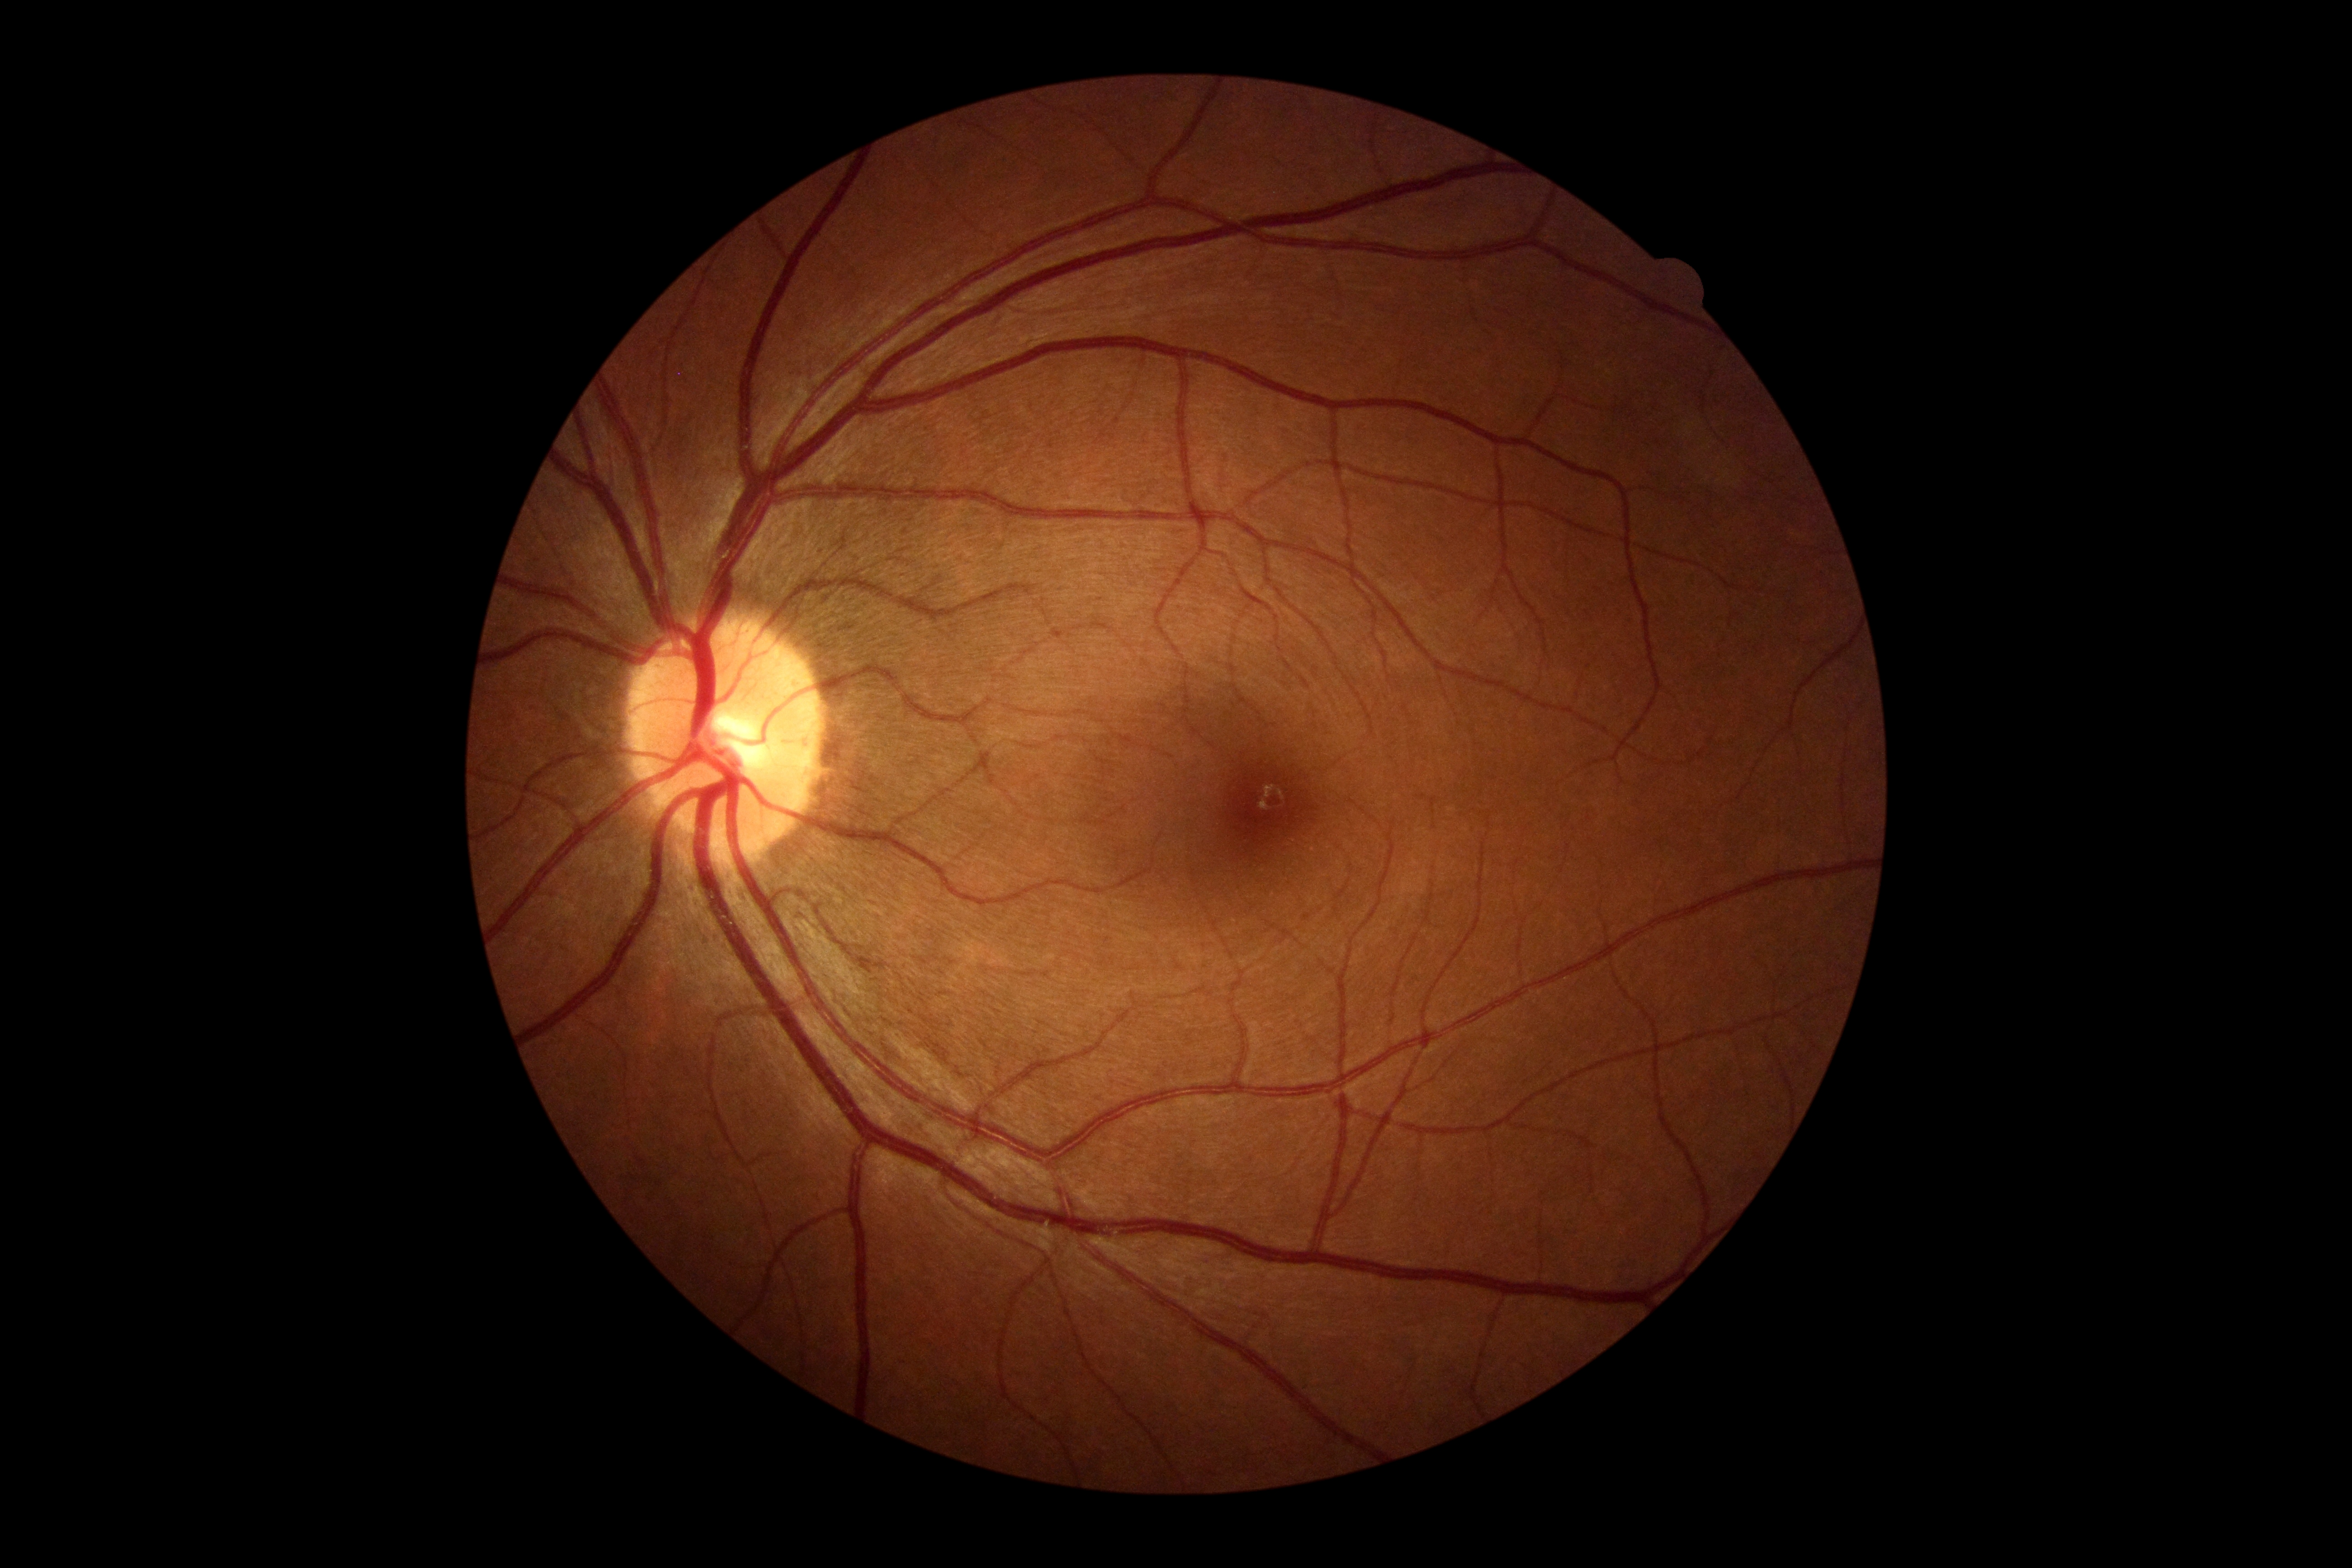

DR severity: no apparent retinopathy (grade 0).